Davis DR grading · without pupil dilation.
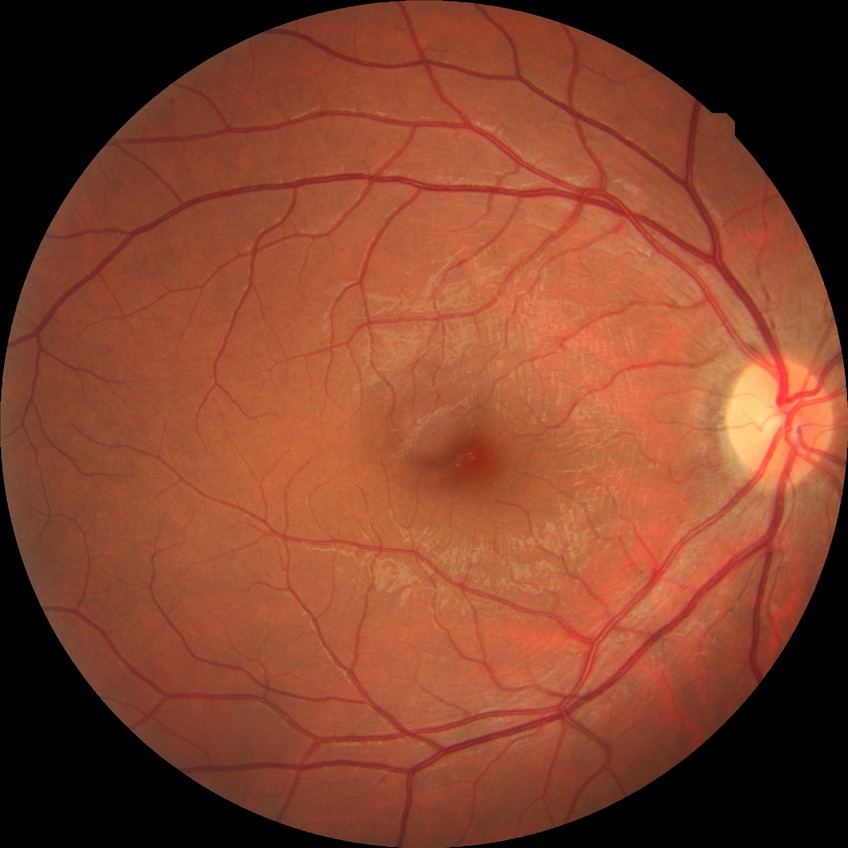 Findings:
• diabetic retinopathy (DR): NDR (no diabetic retinopathy)